512 by 512 pixels: 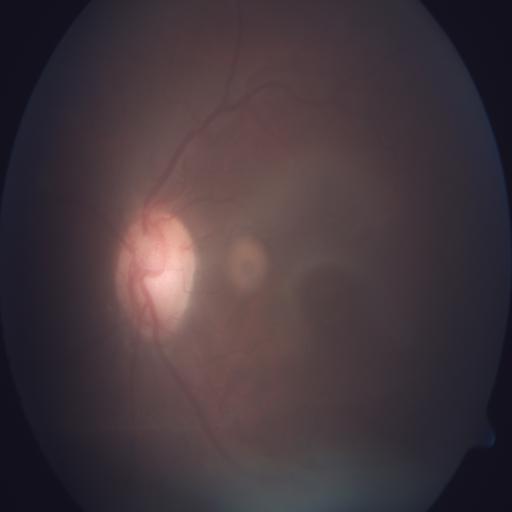 Findings: chorioretinitis.